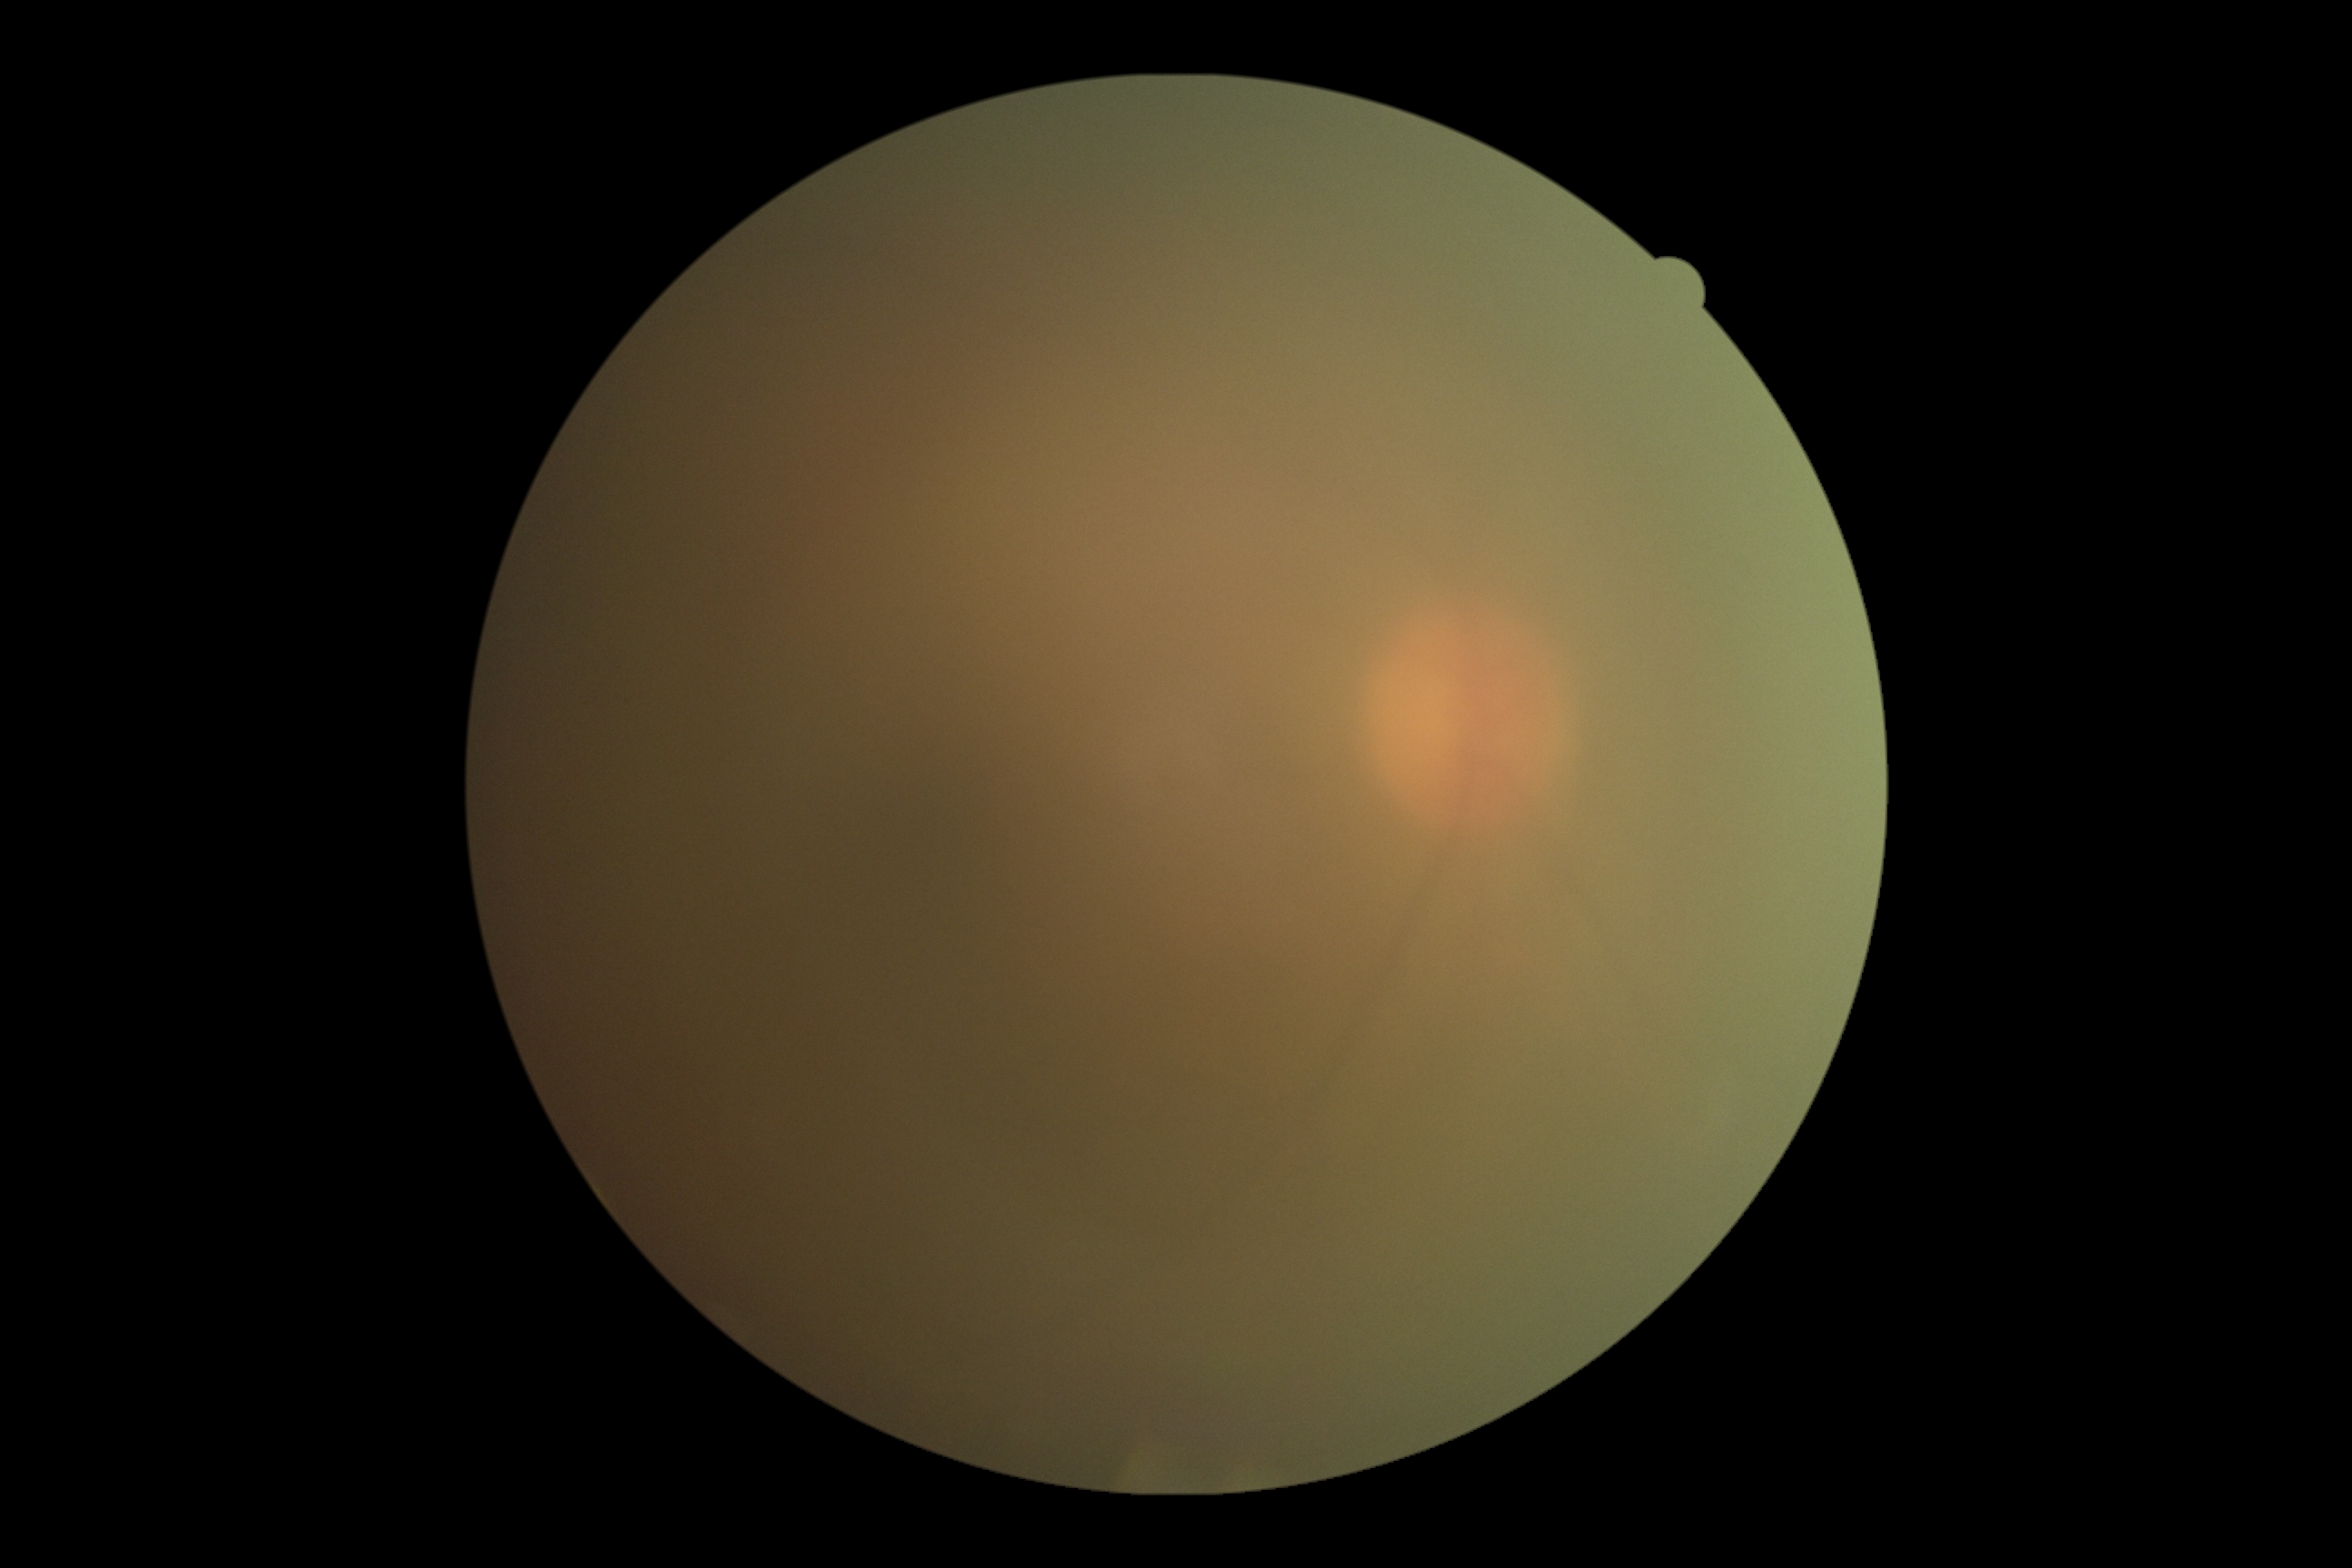
Diabetic retinopathy (DR) is ungradable due to poor image quality. Quality too poor to assess for DR.